Retinal fundus photograph; image size 848x848 — 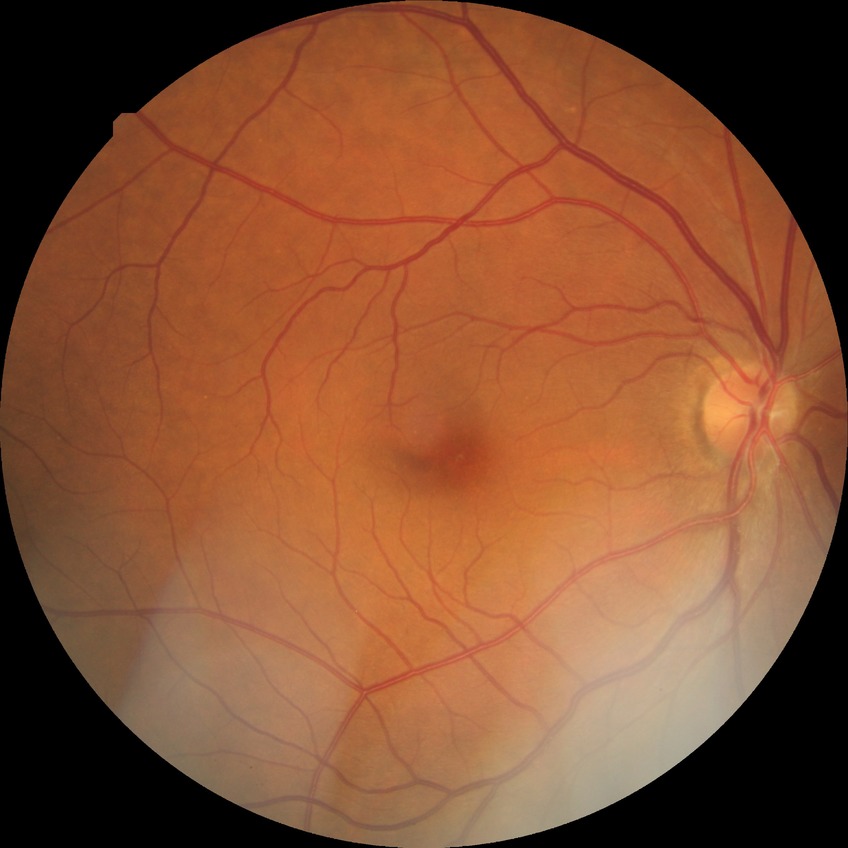

* modified Davis classification — no diabetic retinopathy